Image size 1240x1240 · wide-field fundus photograph from neonatal ROP screening · captured with the Phoenix ICON (100° field of view).
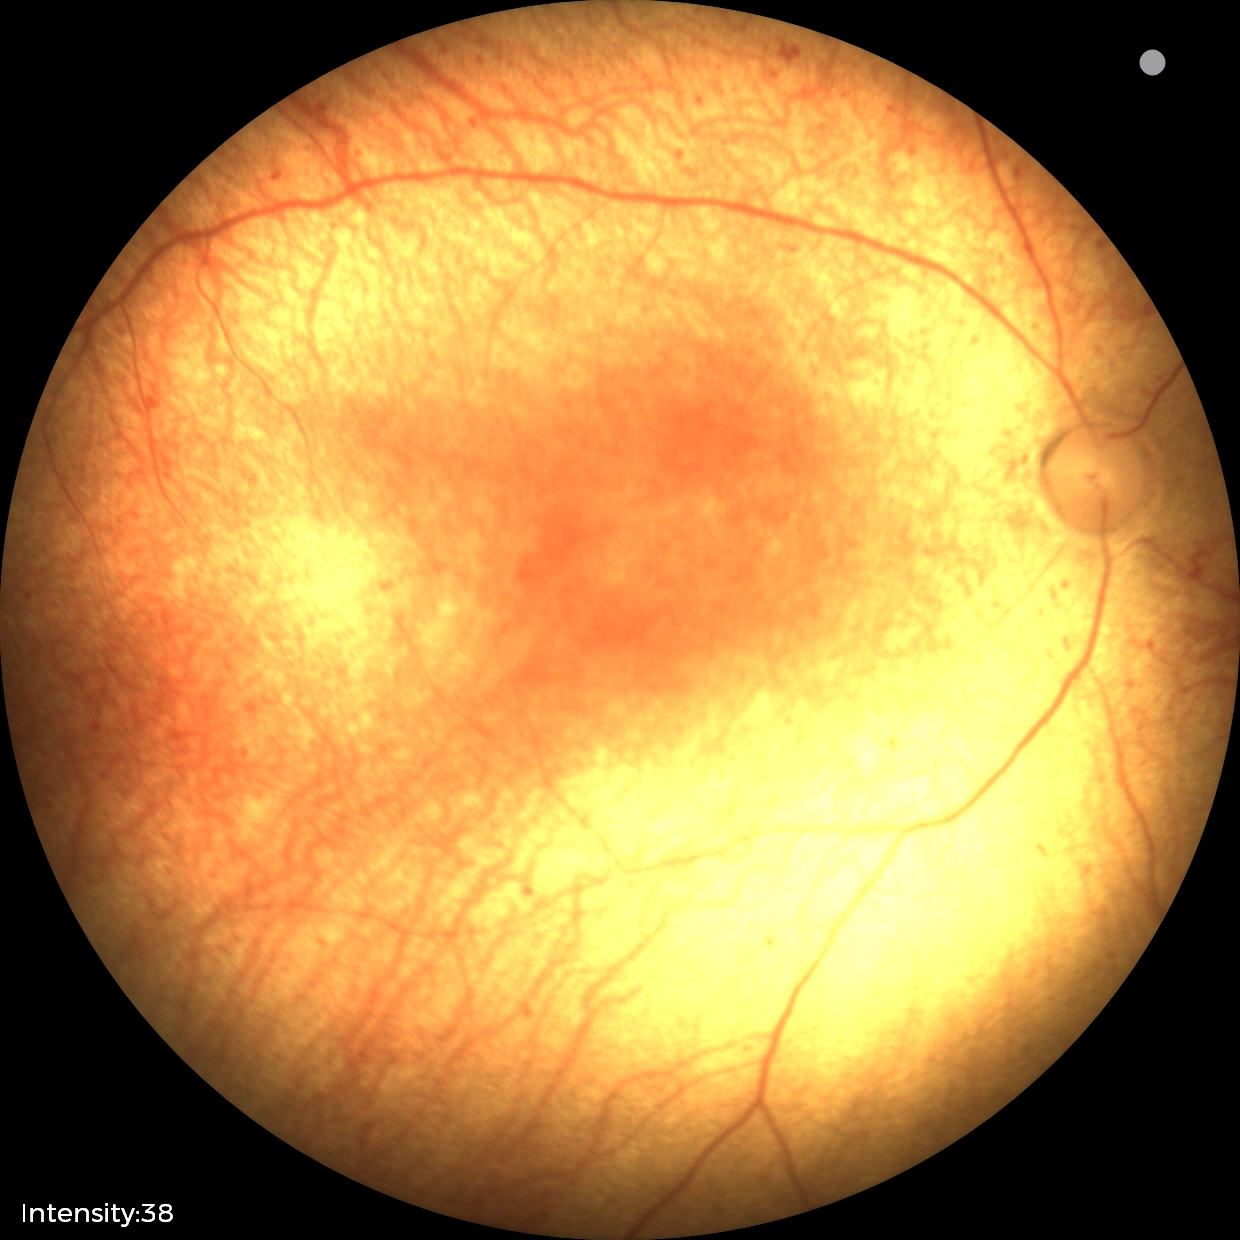
No plus disease. Screening series with status post retinopathy of prematurity.